45° field of view, 2352x1568px
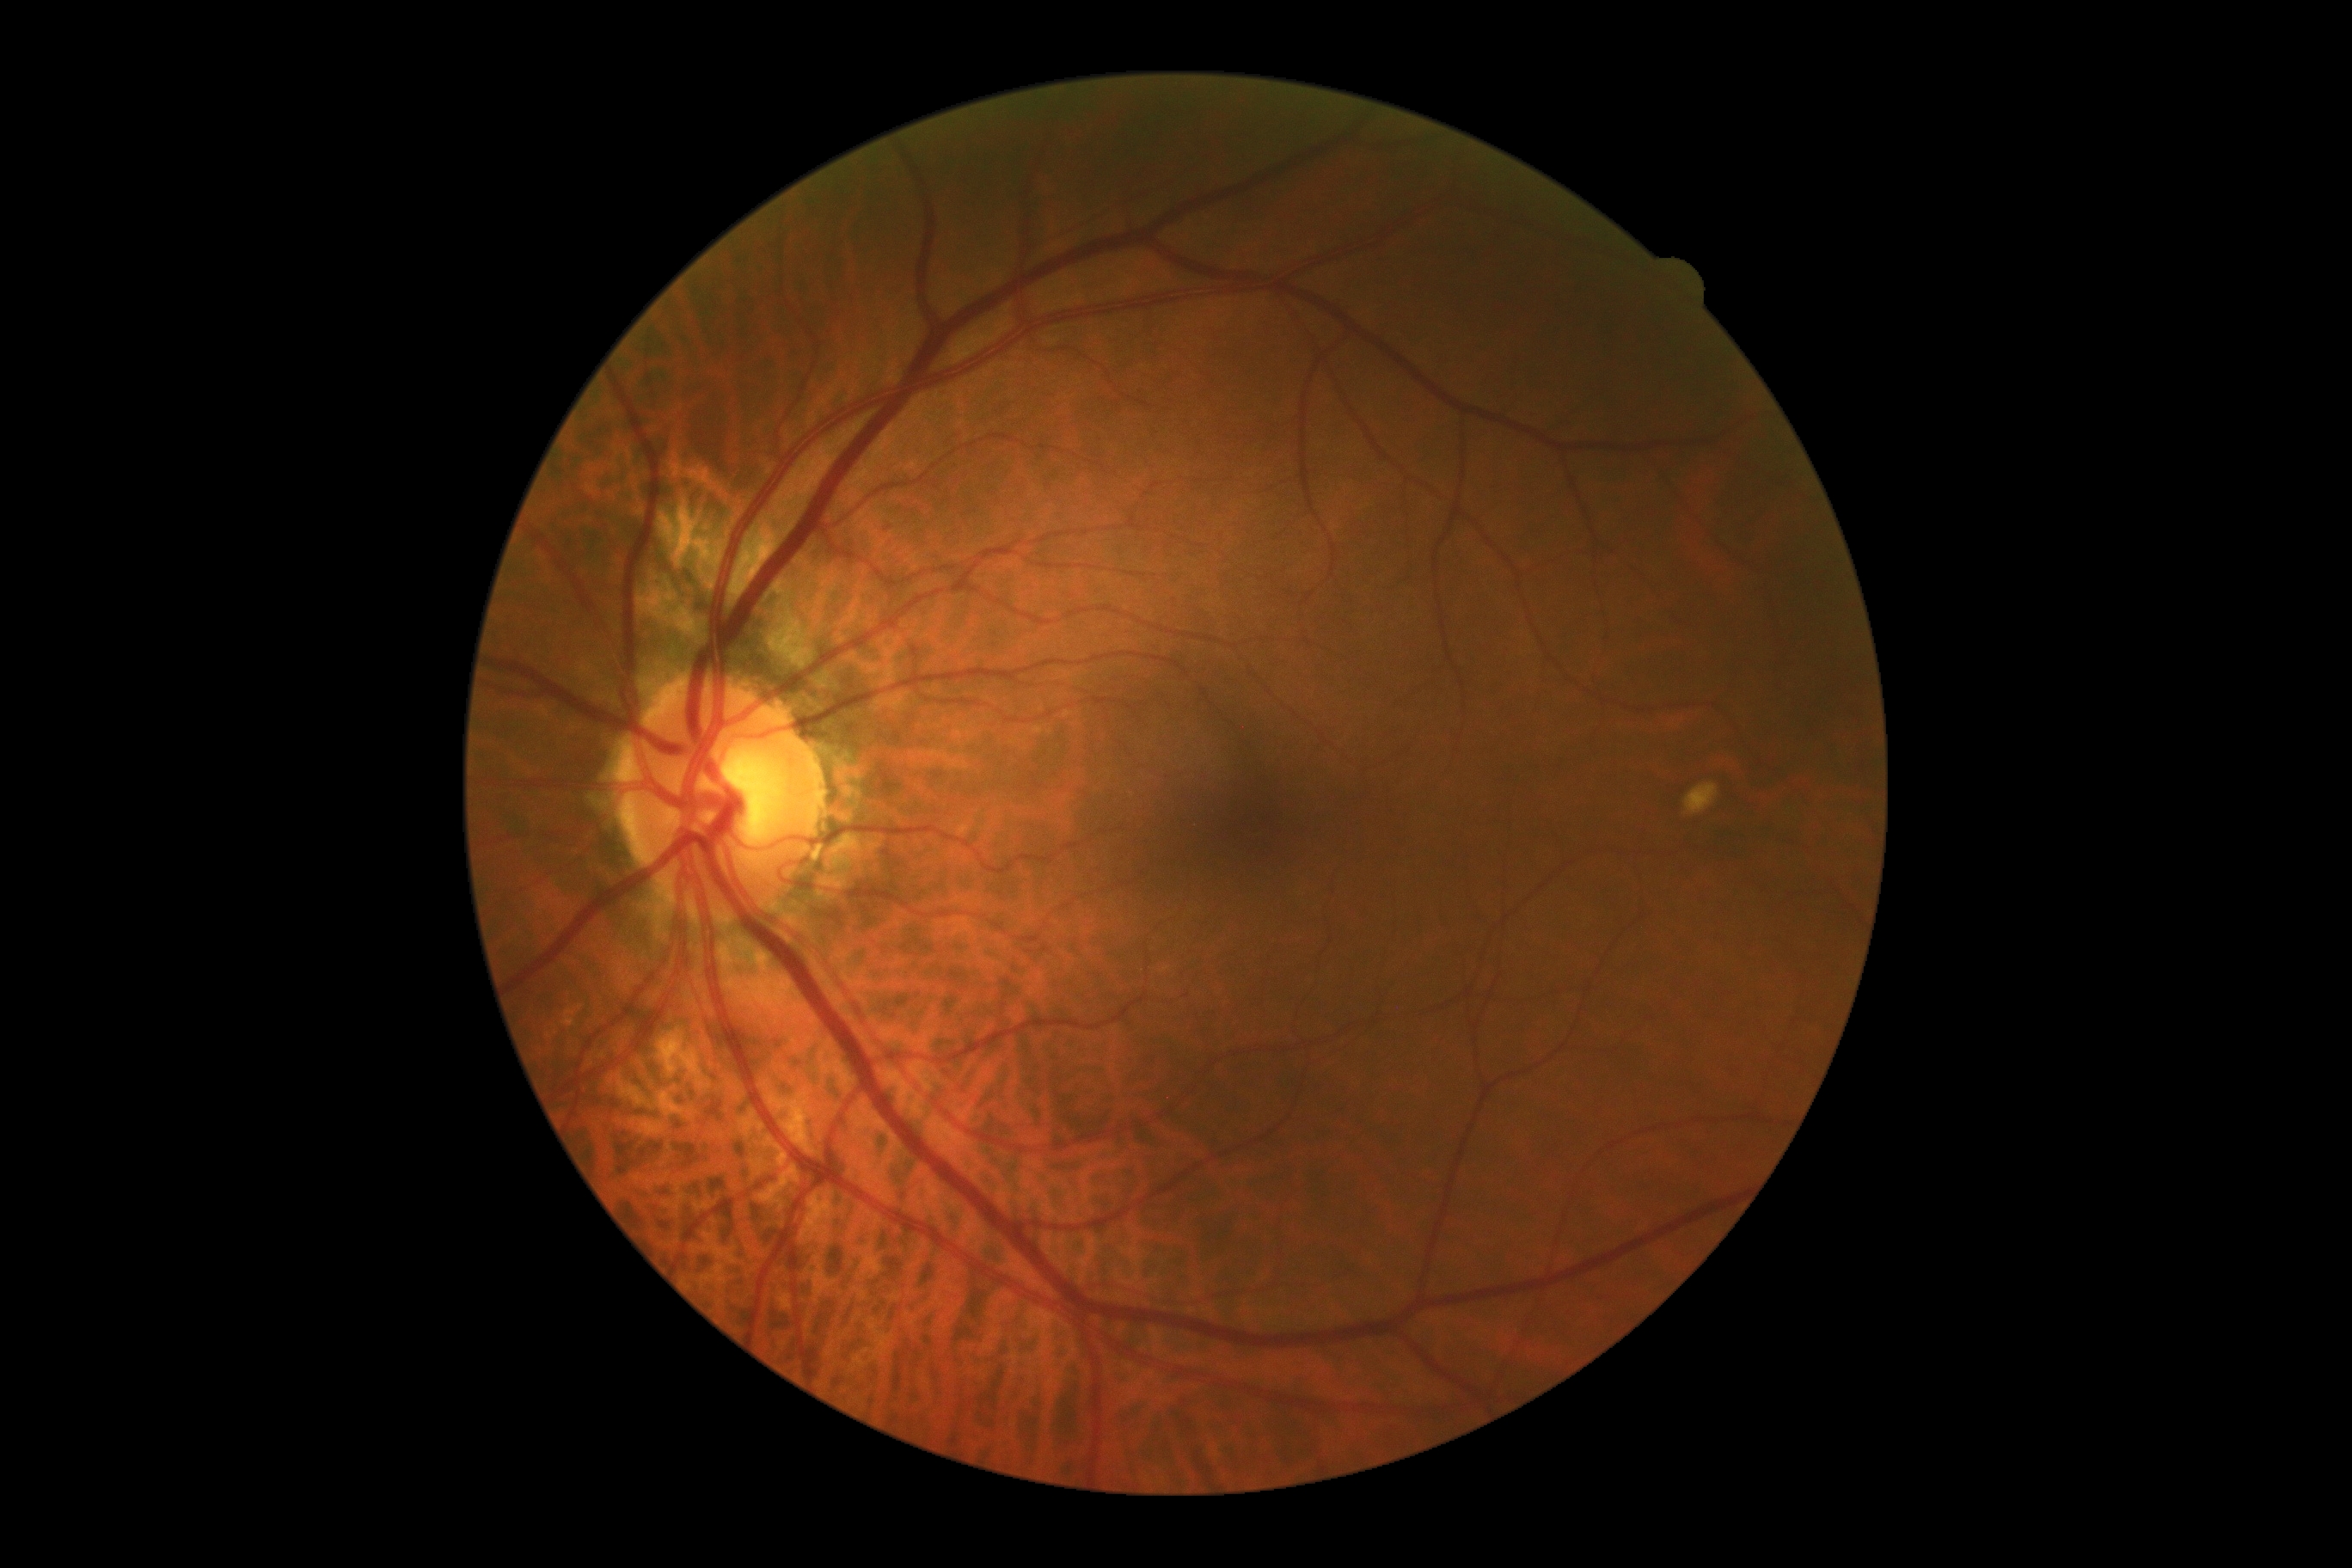
Diabetic retinopathy (DR): grade 0.